FOV: 45 degrees, 848 x 848 pixels, no pharmacologic dilation, color fundus photograph.
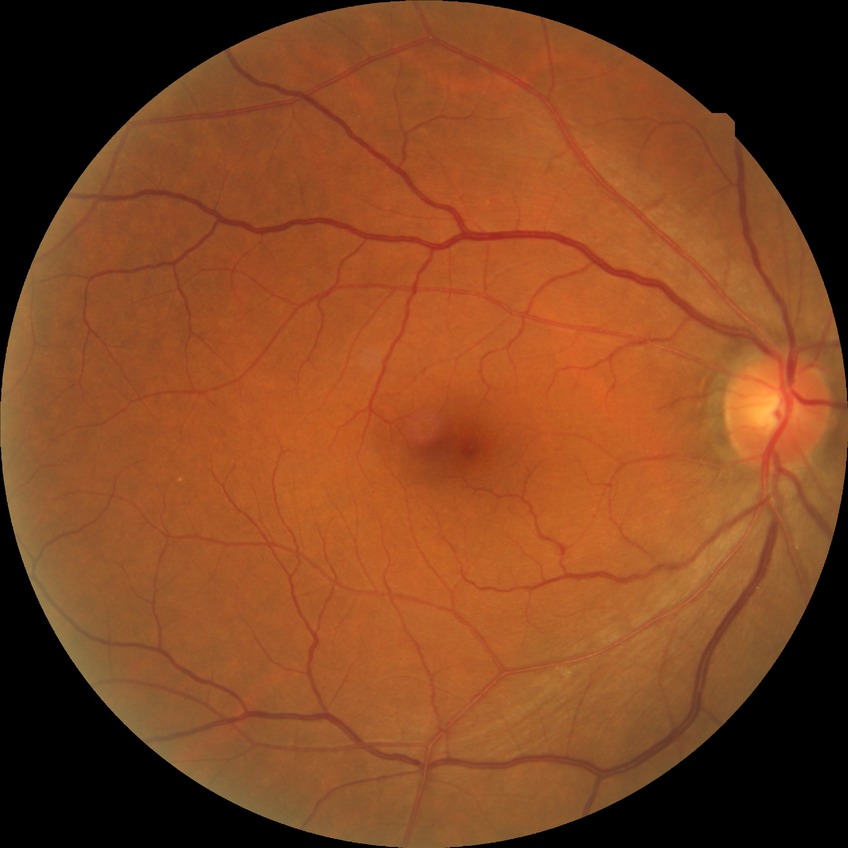 diabetic retinopathy (DR): no diabetic retinopathy (NDR).